1920x1088px: 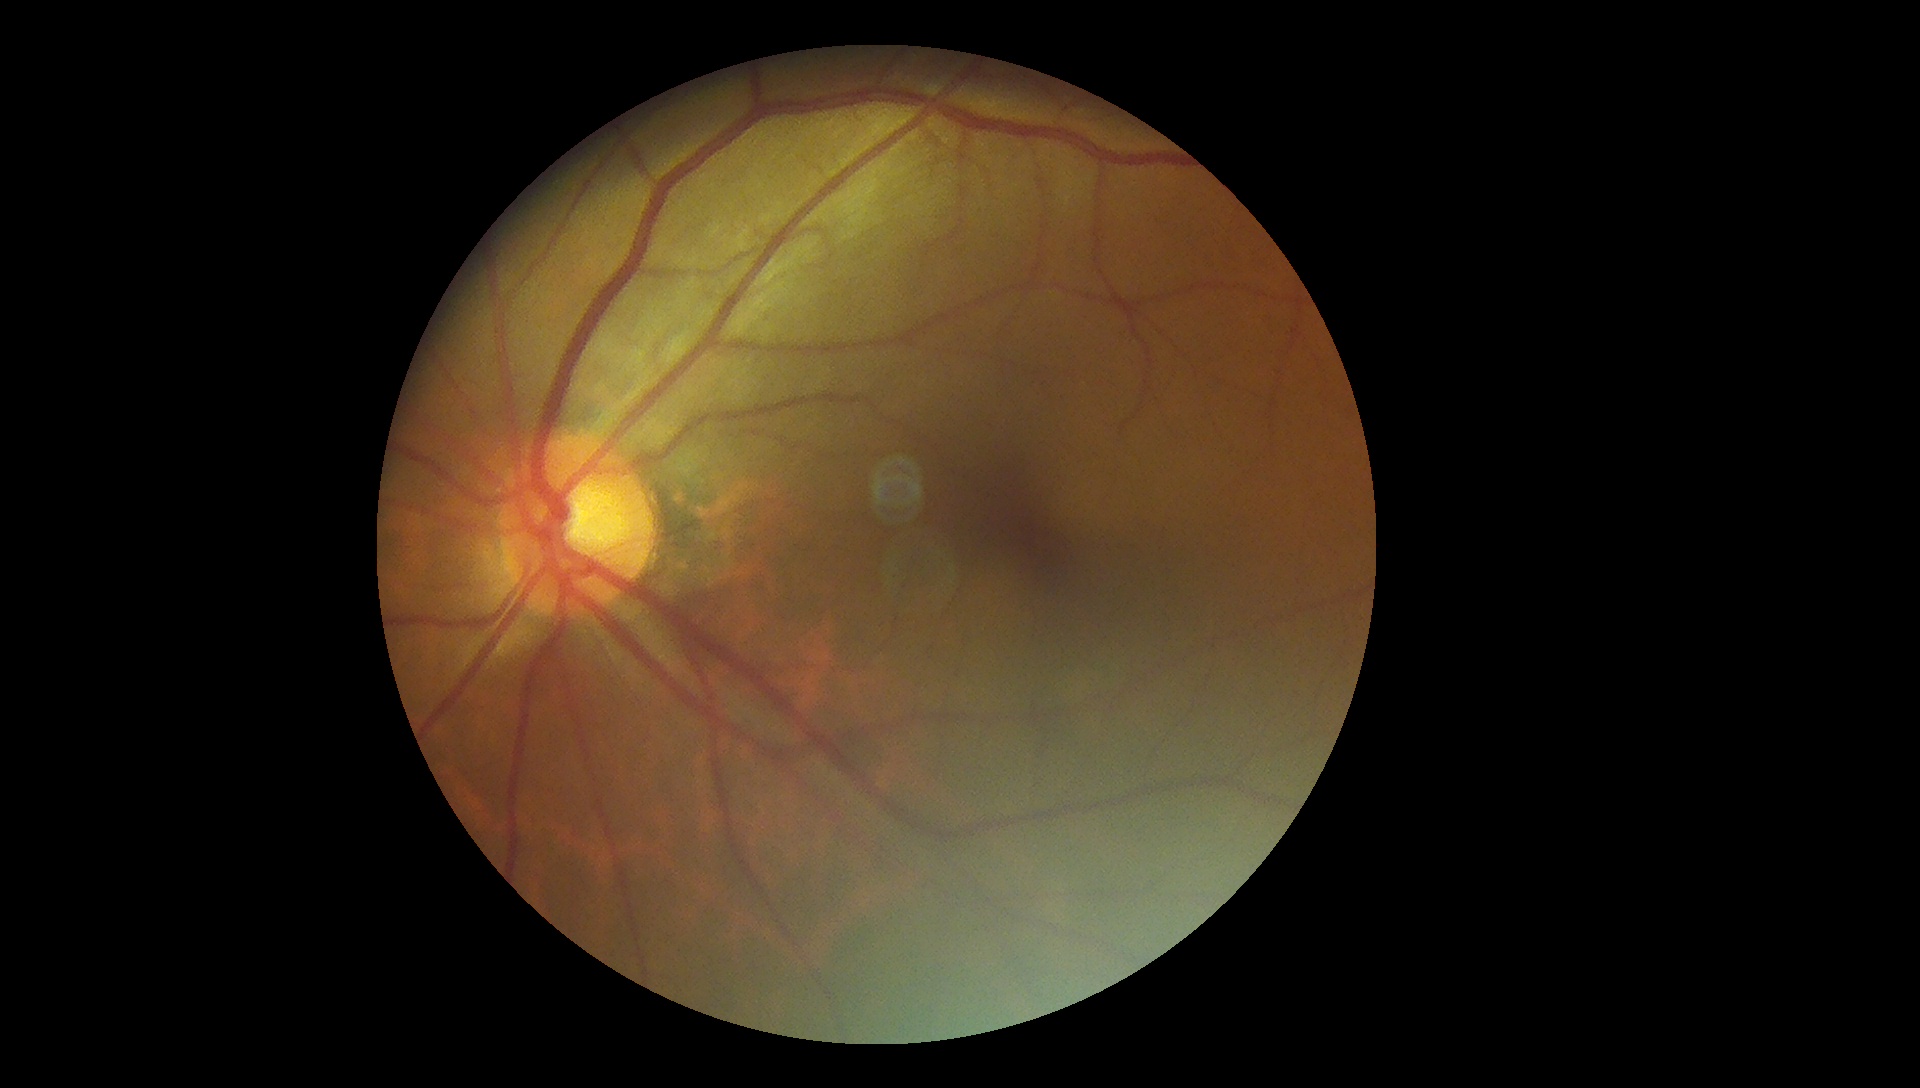

Diabetic retinopathy severity: grade 0 (no apparent retinopathy).